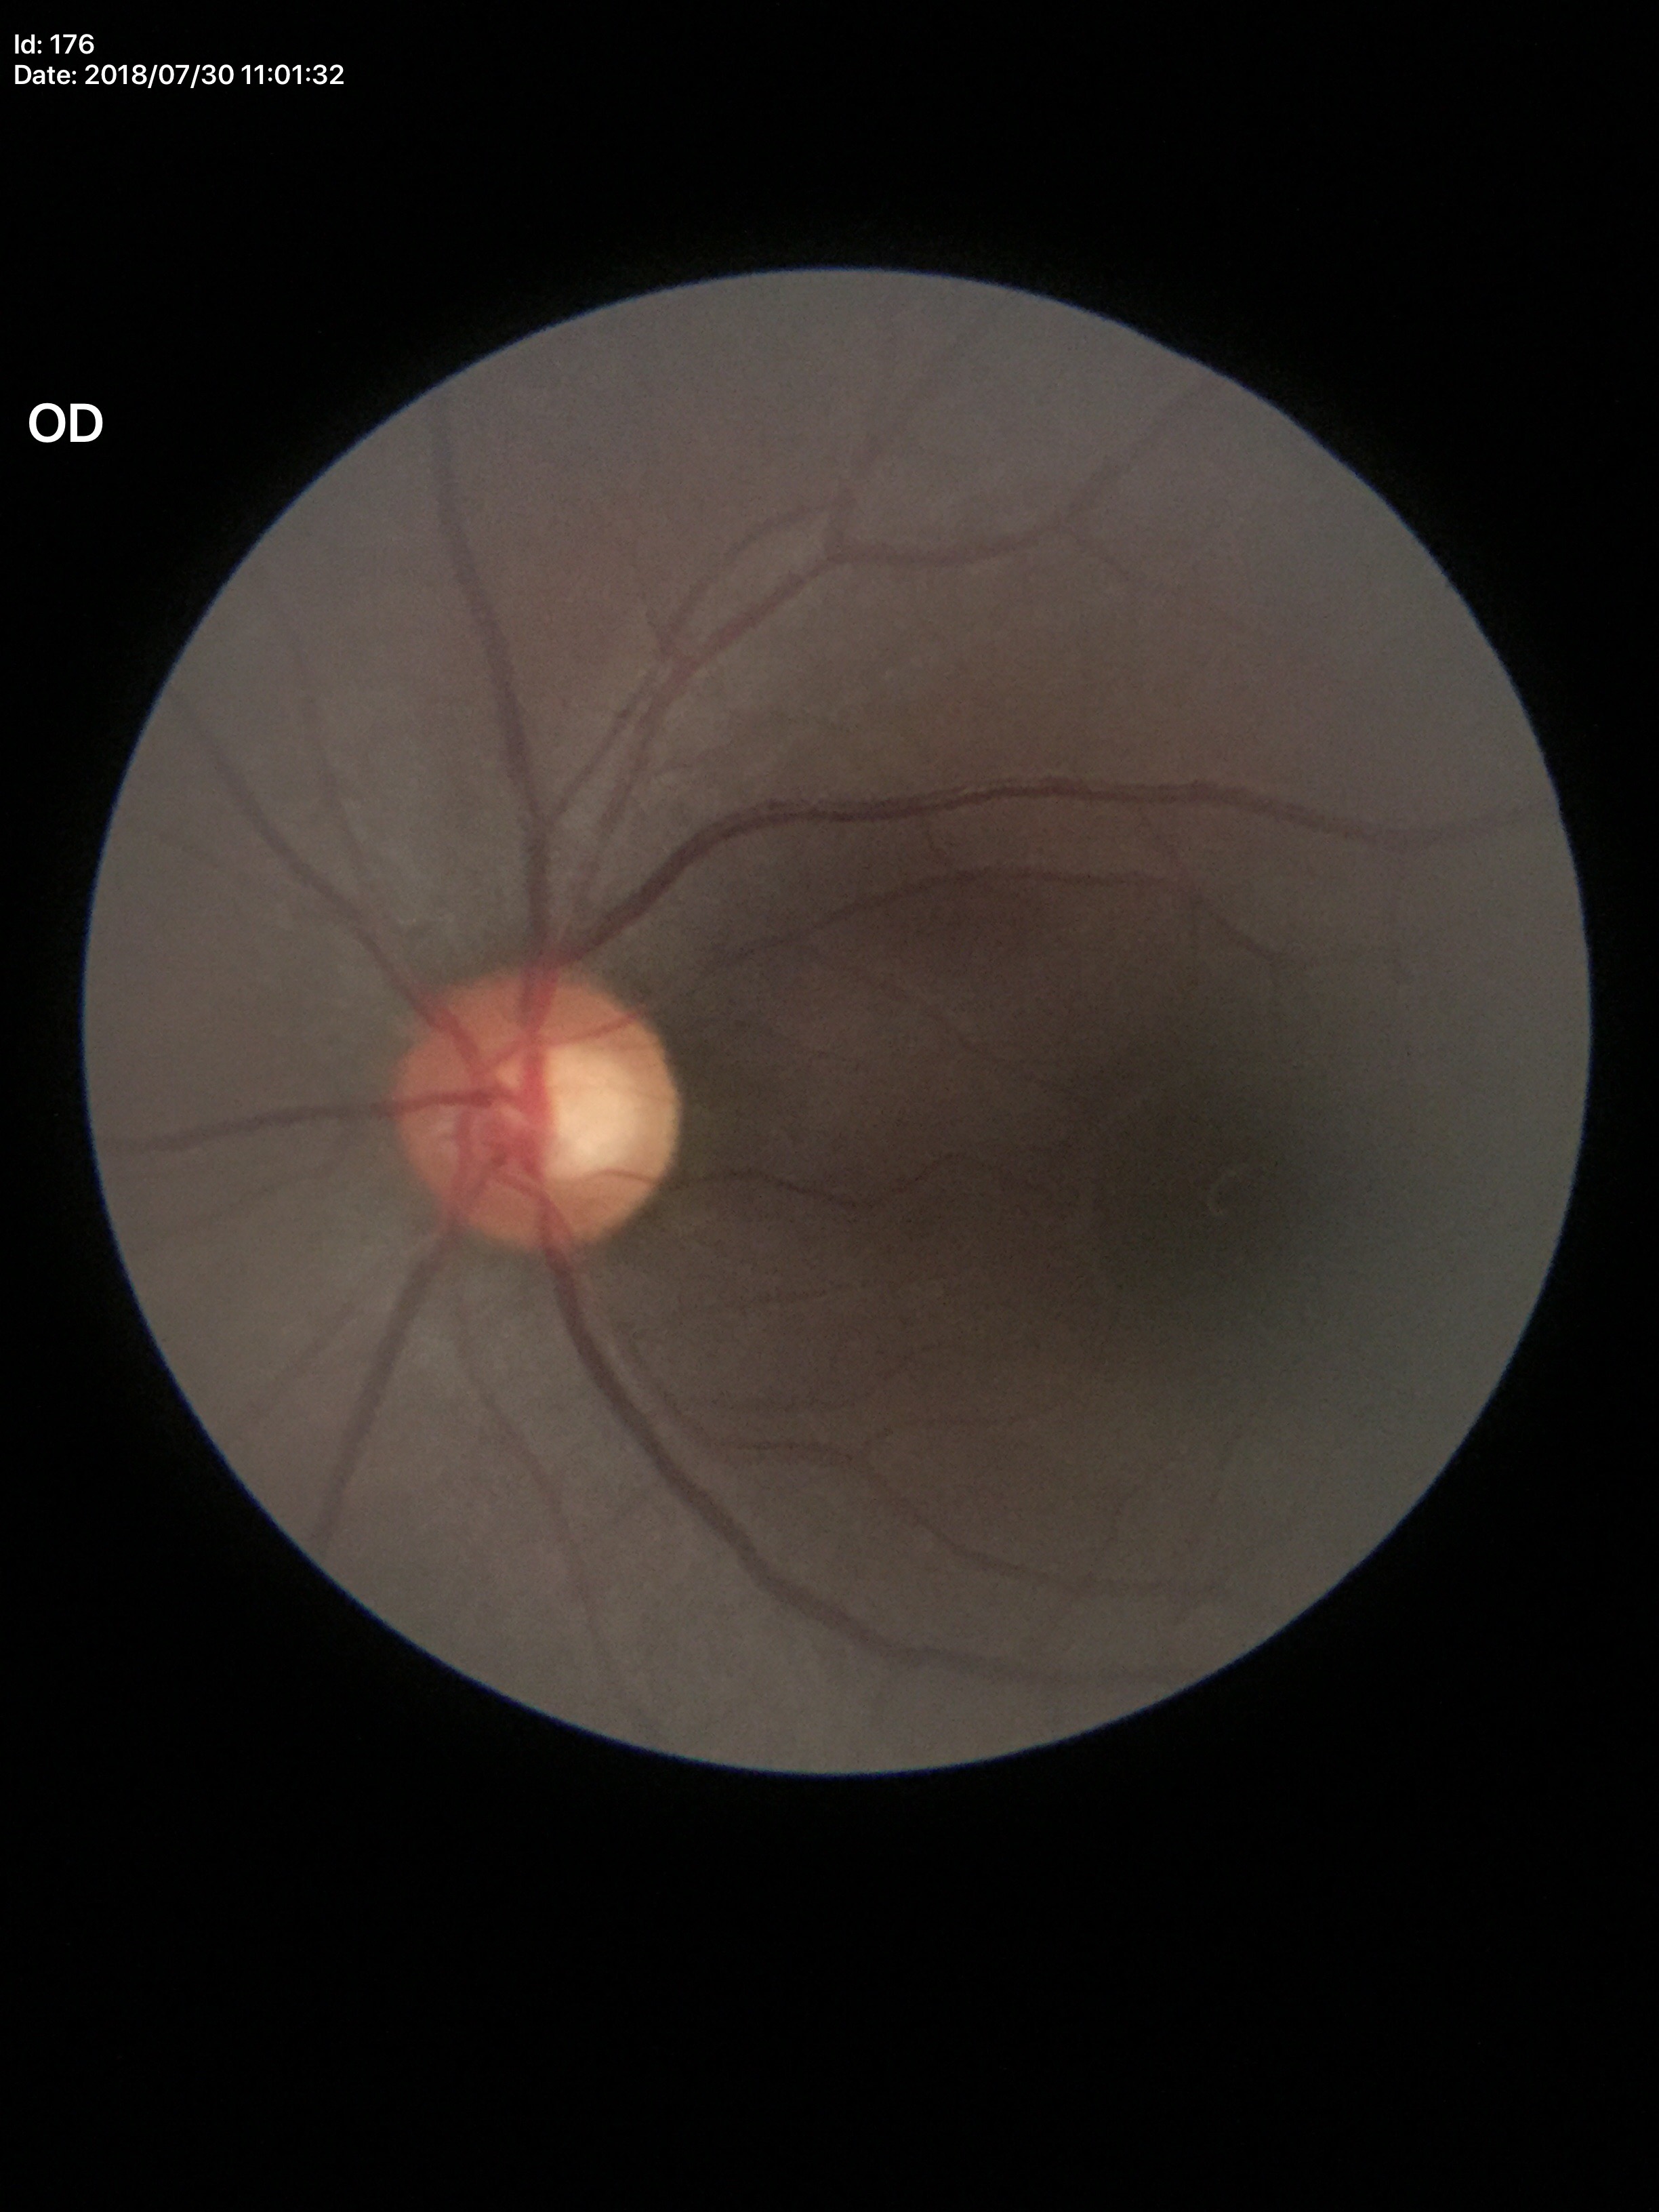 Glaucoma evaluation=negative; vertical cup-to-disc ratio=0.59; horizontal cup-disc ratio=0.62